Infant wide-field retinal image. Captured with the Clarity RetCam 3 (130° field of view) — 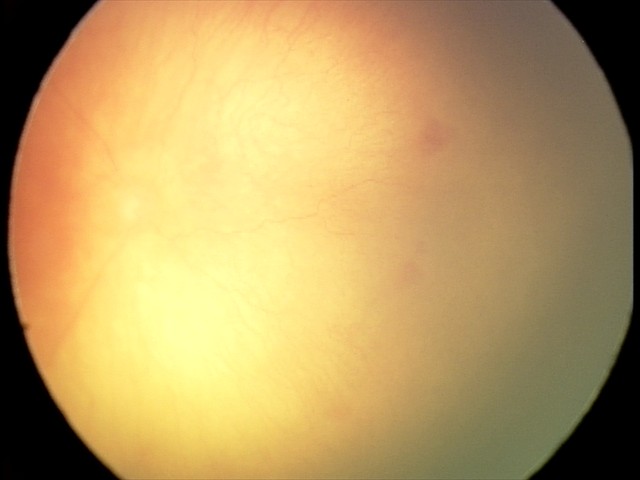

Q: Is plus disease present?
A: plus disease — abnormal dilation and tortuosity of the posterior pole retinal vessels
Q: What was the screening finding?
A: A-ROP (aggressive ROP)